DR severity per modified Davis staging — 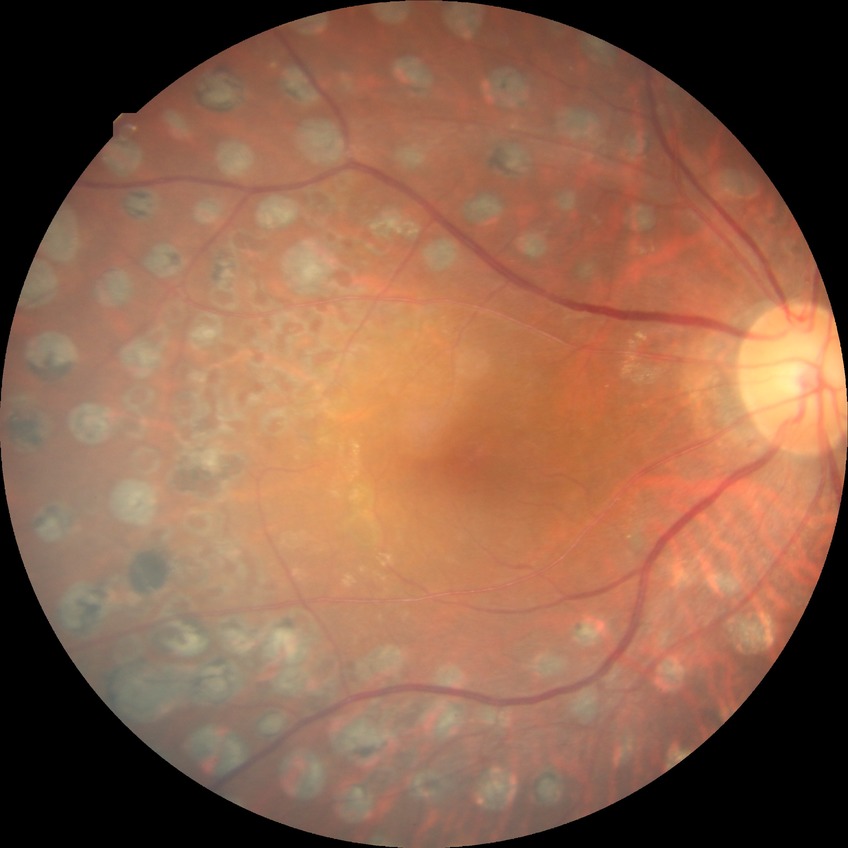

Davis DR grade: PDR